Ultra-widefield fundus photograph.
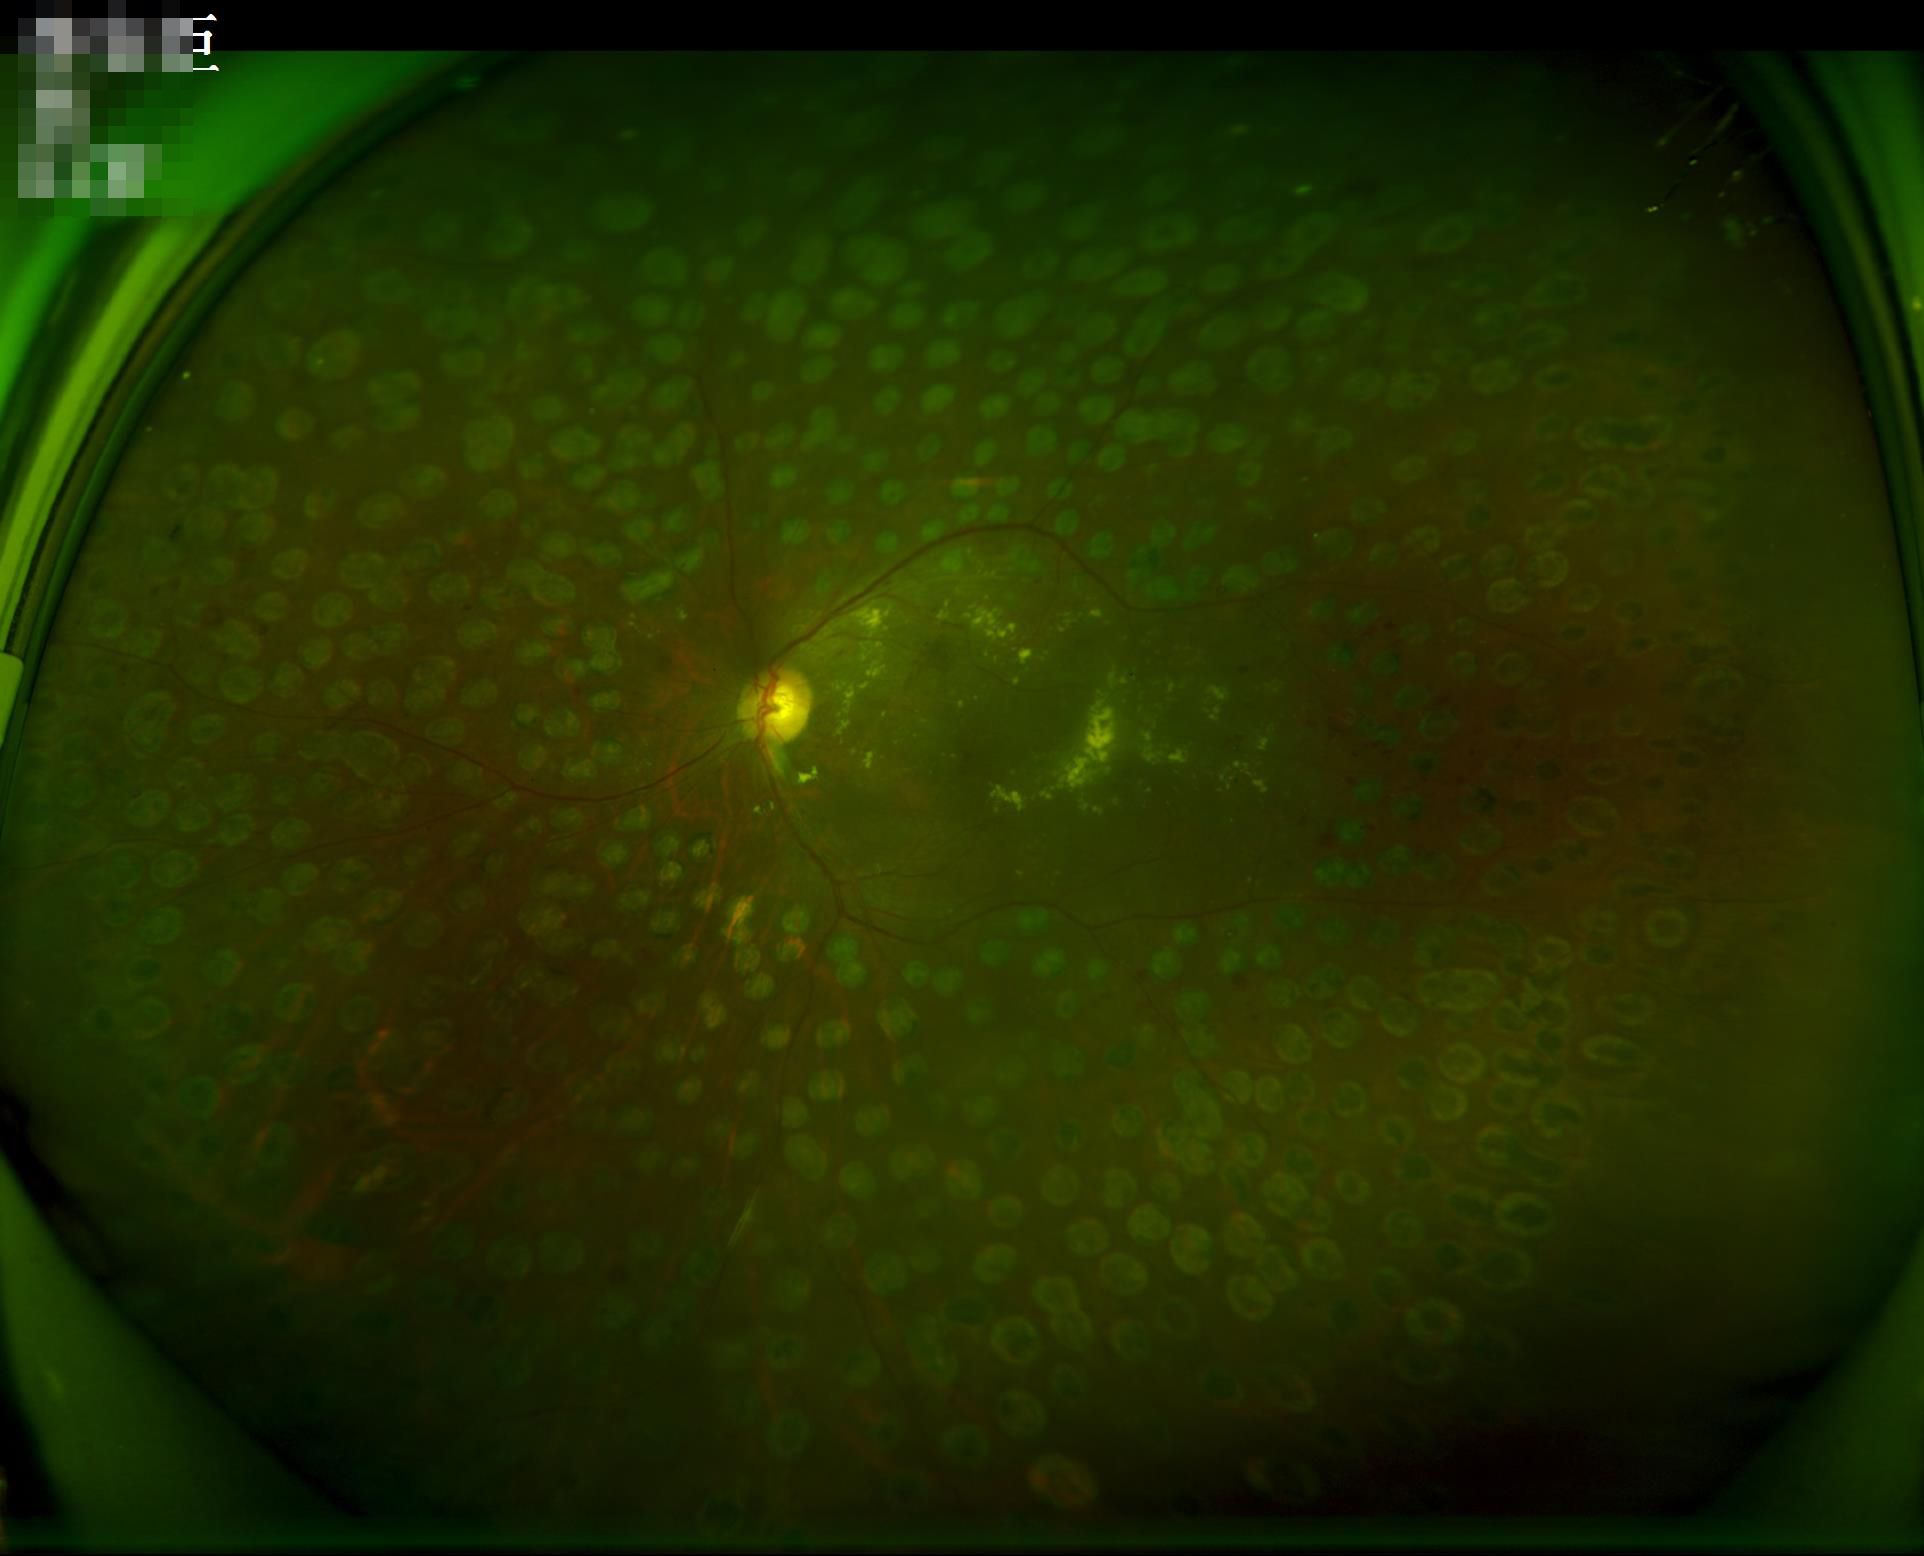

Vessels and details are readily distinguishable. No noticeable blur. Image quality is adequate for diagnostic use. There is over- or under-exposure or a color cast.